1240x1240px · pediatric wide-field fundus photograph:
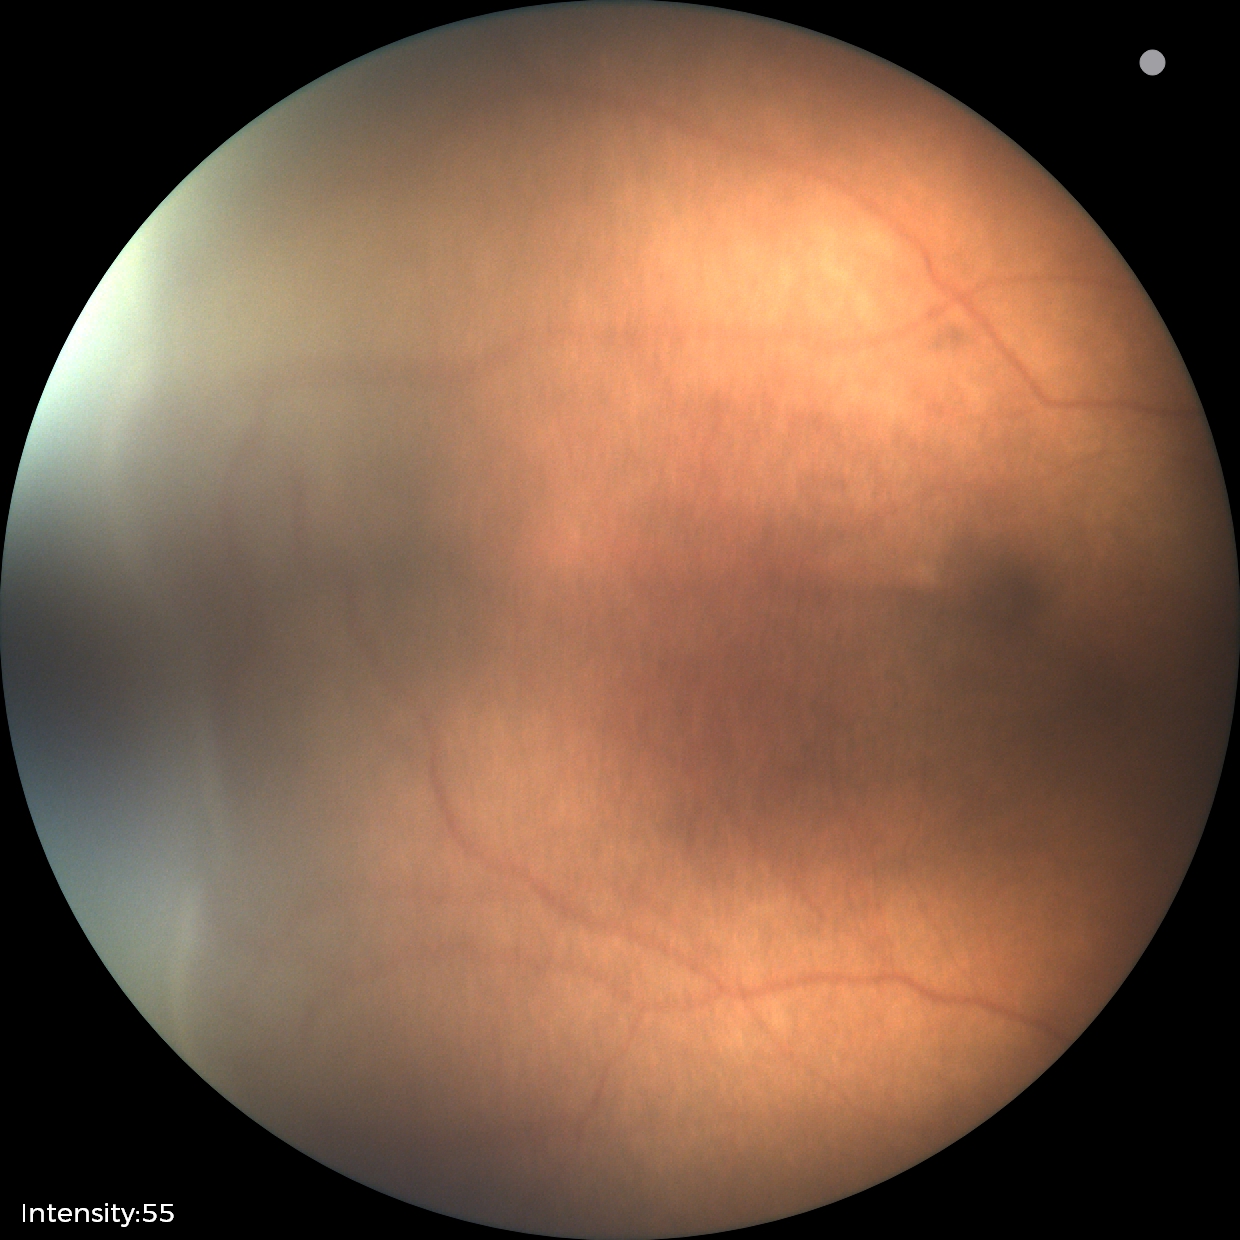
Screening diagnosis = retinopathy of prematurity (ROP) stage 2
plus form = absent